100° field of view (Phoenix ICON) · 1240x1240 · wide-field fundus image from infant ROP screening
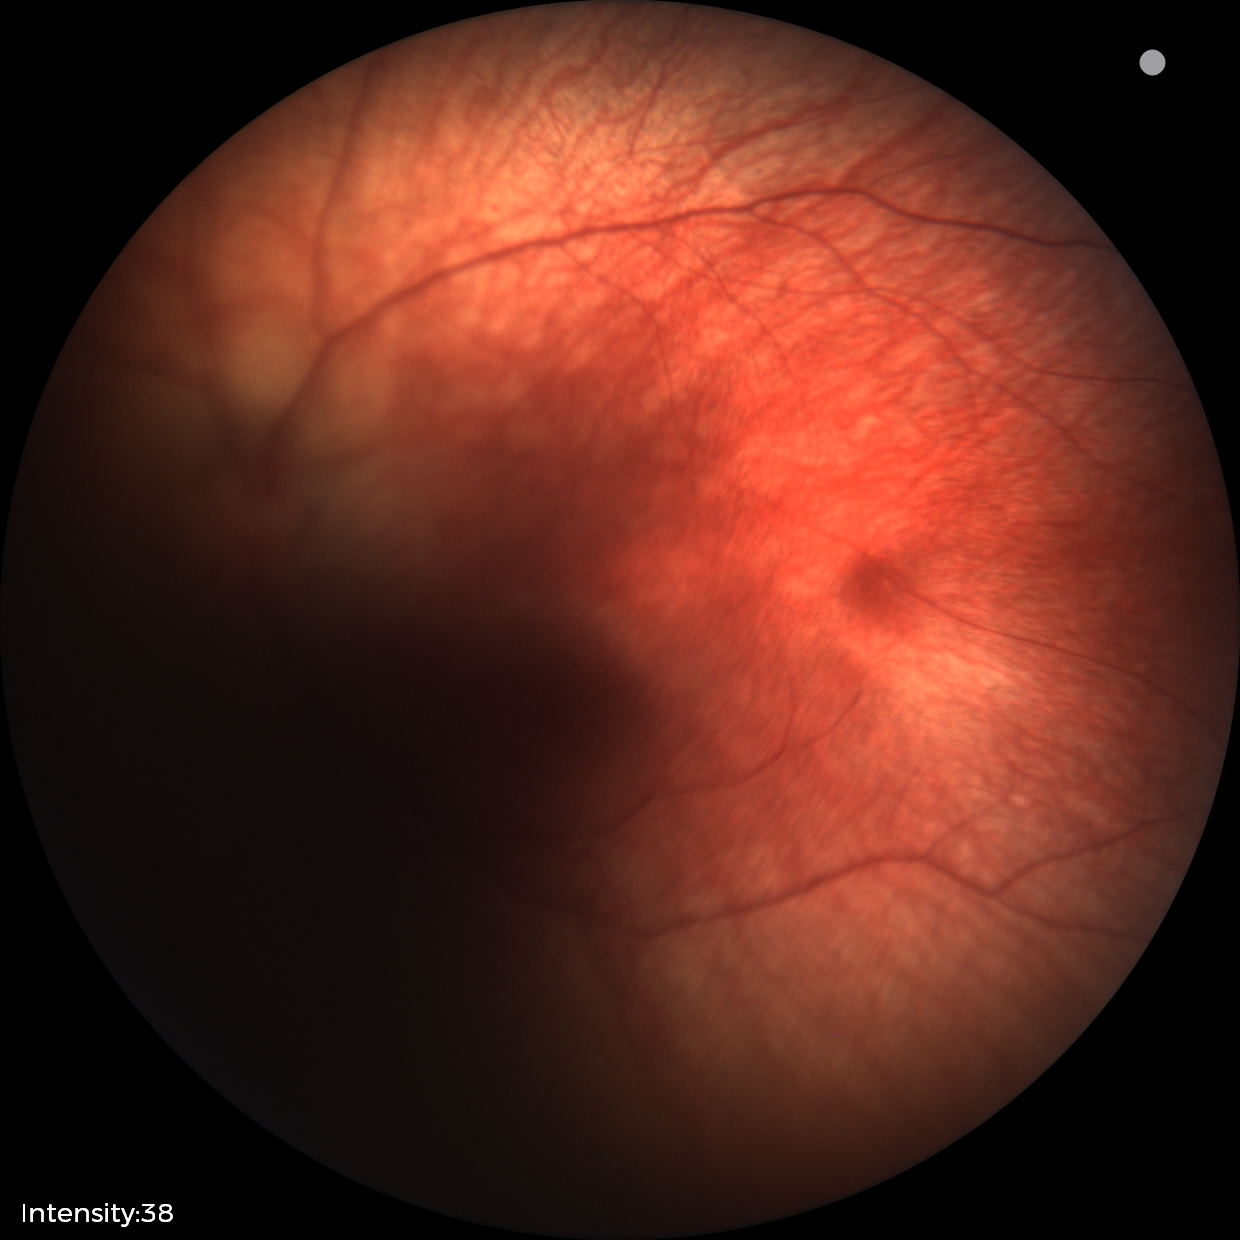

Examination with physiological retinal findings.